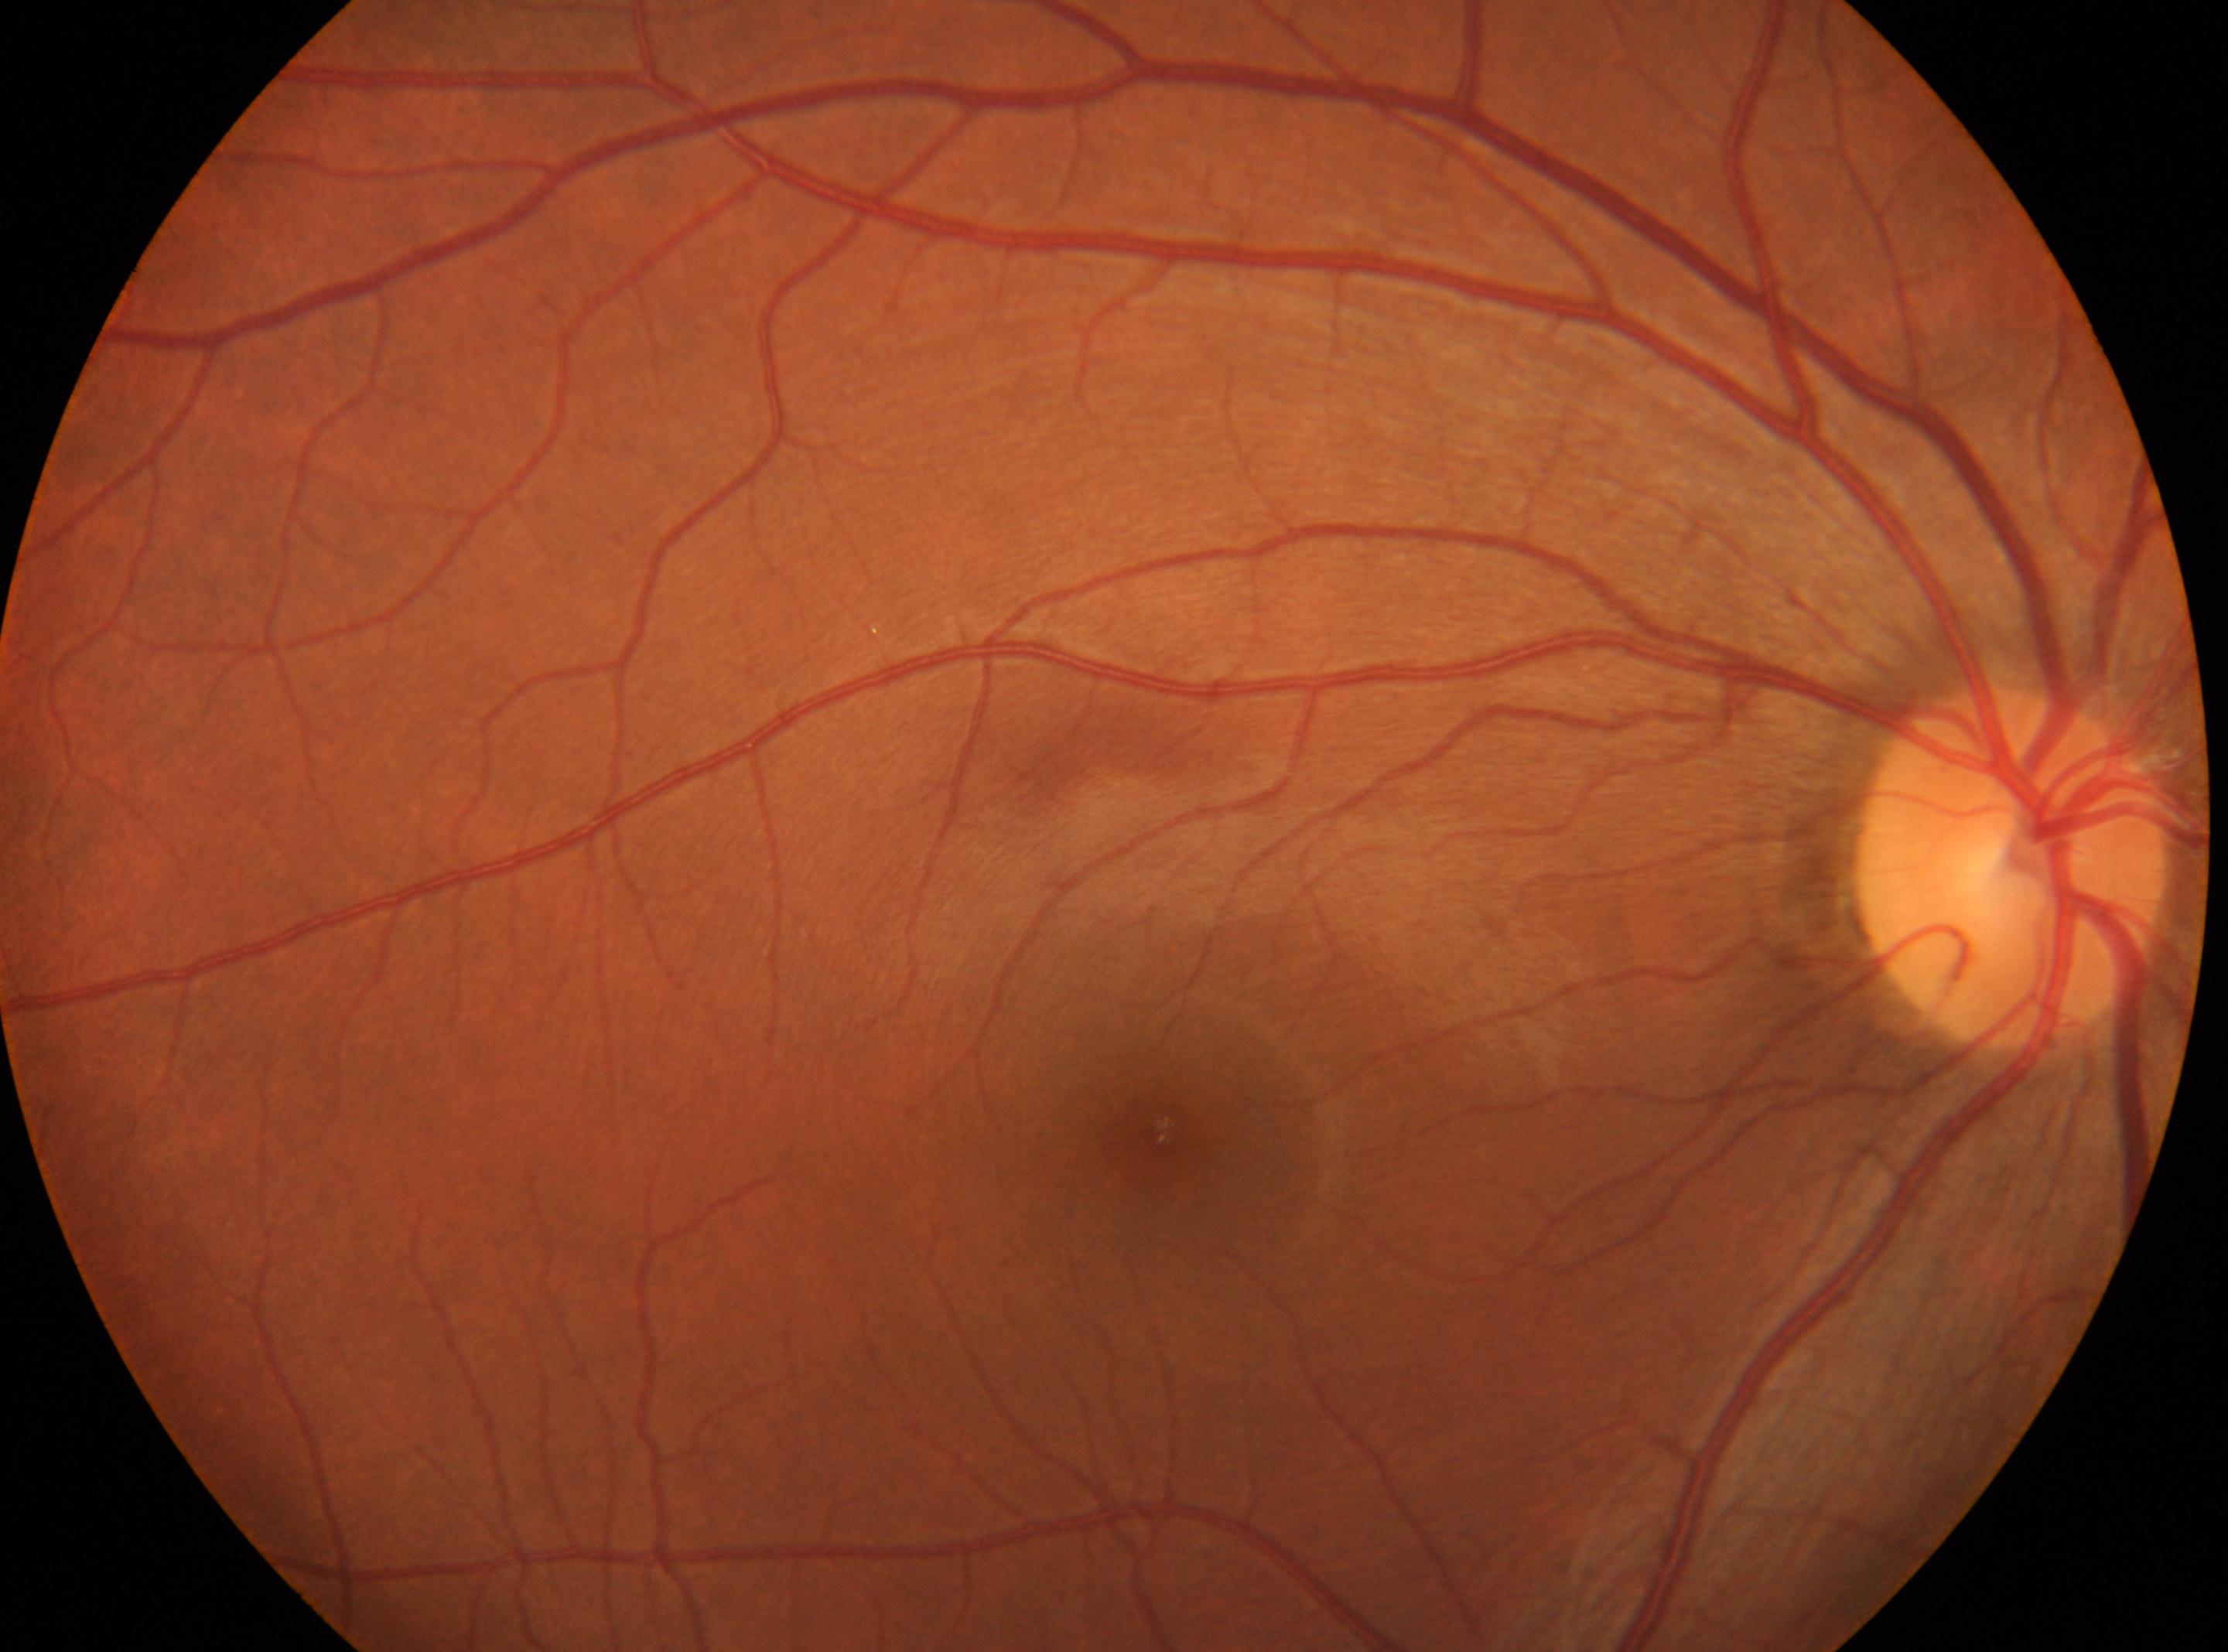
Annotations:
* diabetic retinopathy (DR) · grade 0 (no apparent retinopathy) — no visible signs of diabetic retinopathy
* macular center · 1162px, 1129px
* laterality · oculus dexter
* optic disc center · 2013px, 864px